Topcon TRC-50DX — 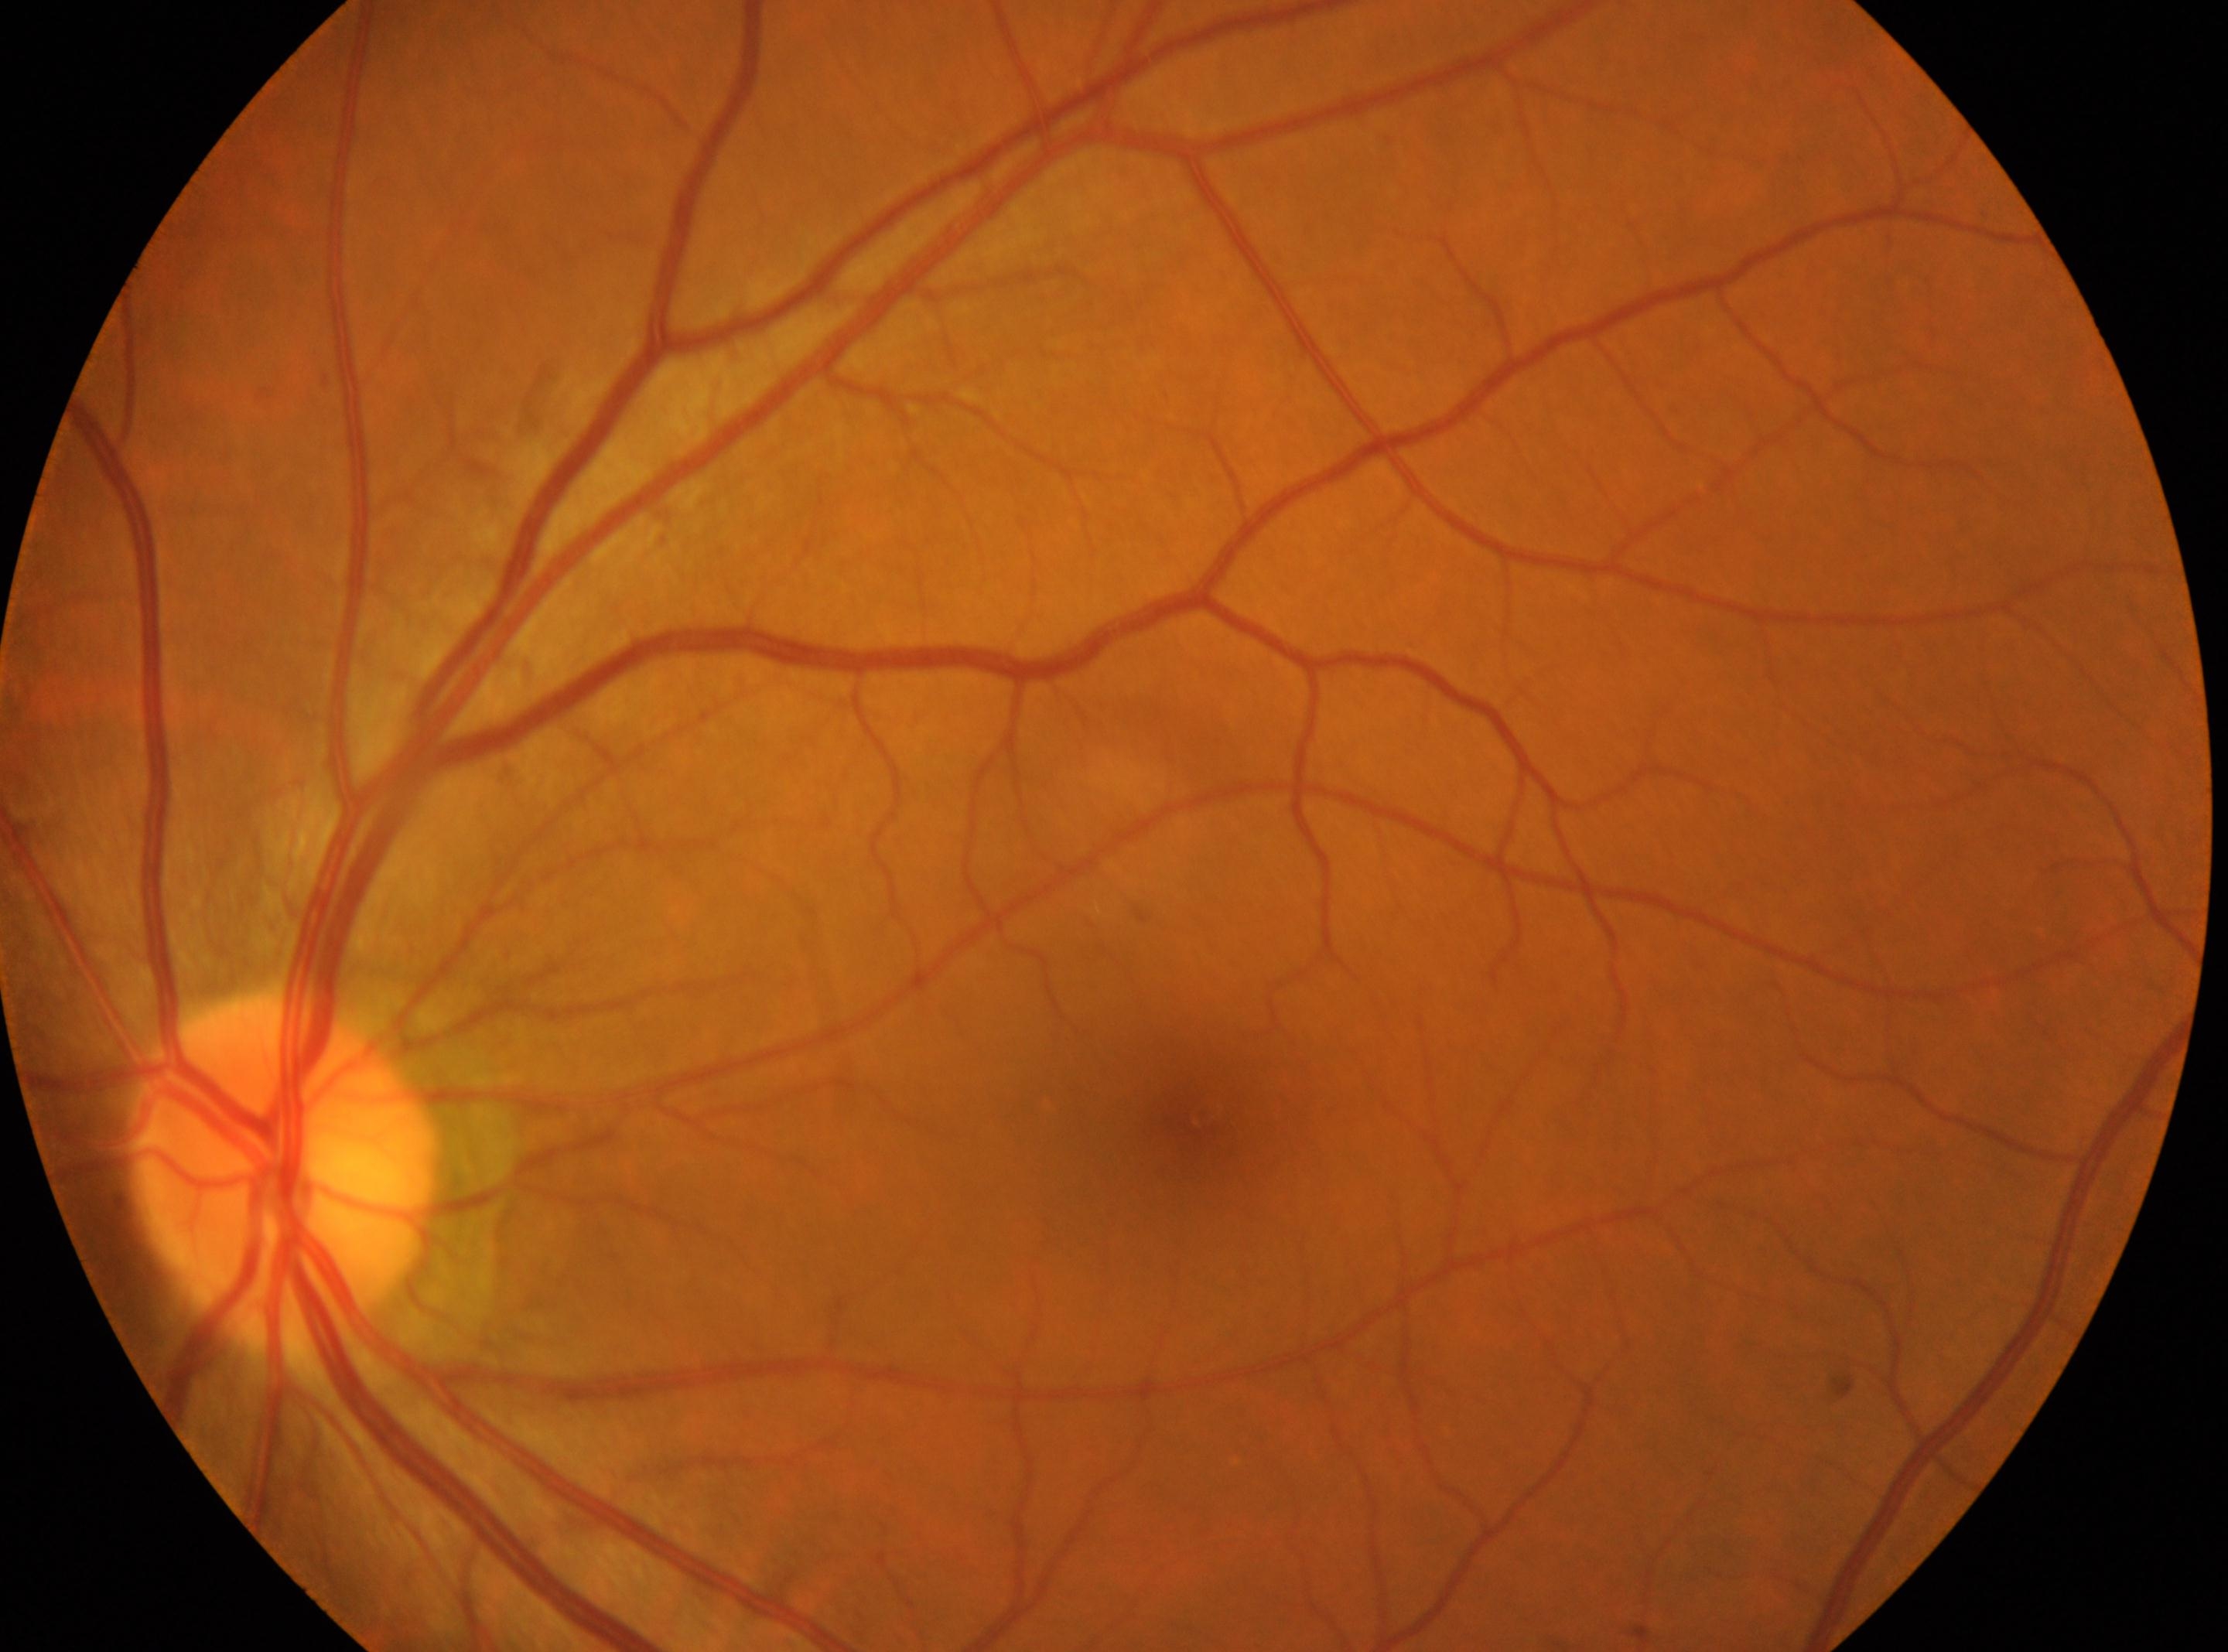

The image shows the left eye. Retinopathy grade: 0. Macula center located at (1194, 1112). No diabetic retinopathy identified. Optic nerve head located at (282, 1172).